Diabetic retinopathy graded by the modified Davis classification:
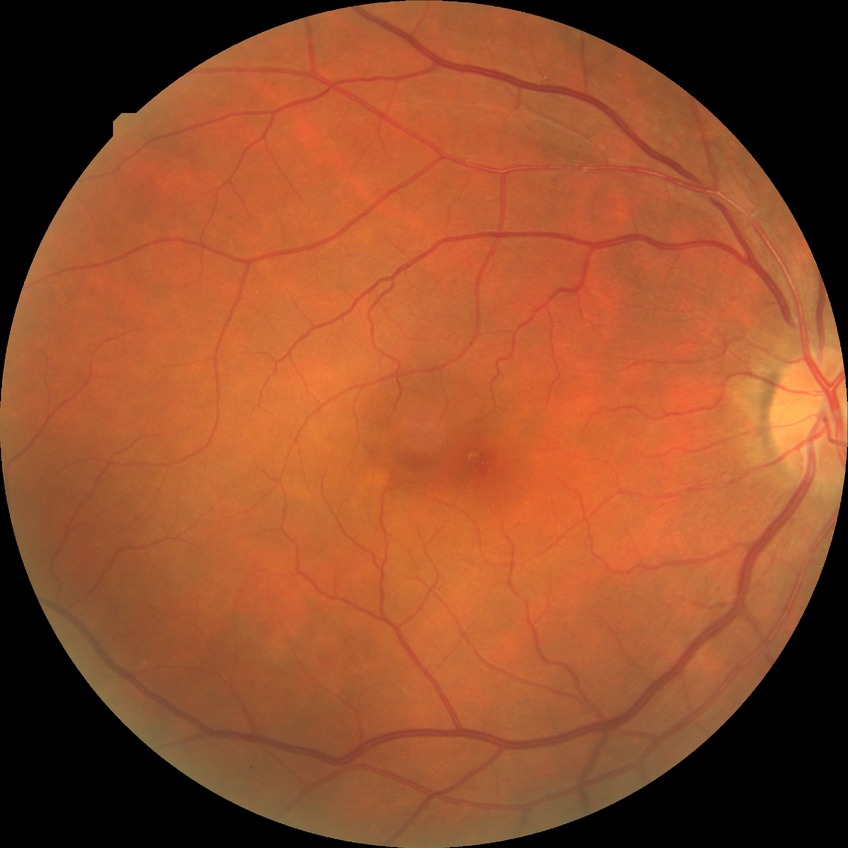 davis_grade: NDR